Wide-field contact fundus photograph of an infant · captured with the Phoenix ICON (100° field of view)
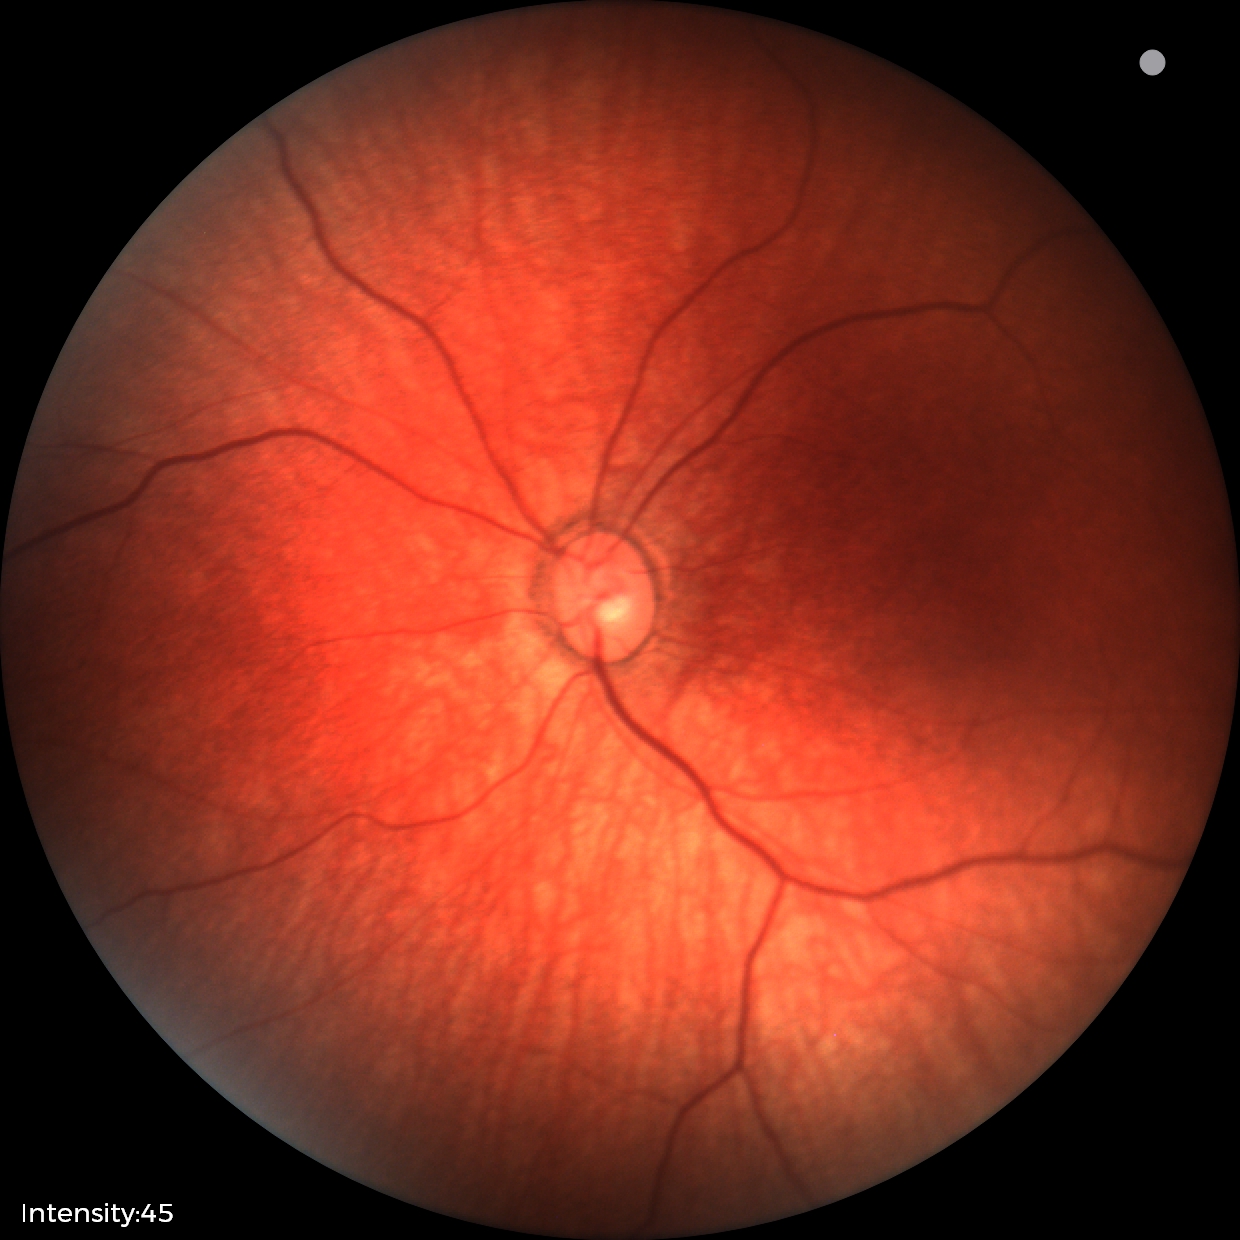
Screening diagnosis = normal.